45° field of view; color fundus photograph:
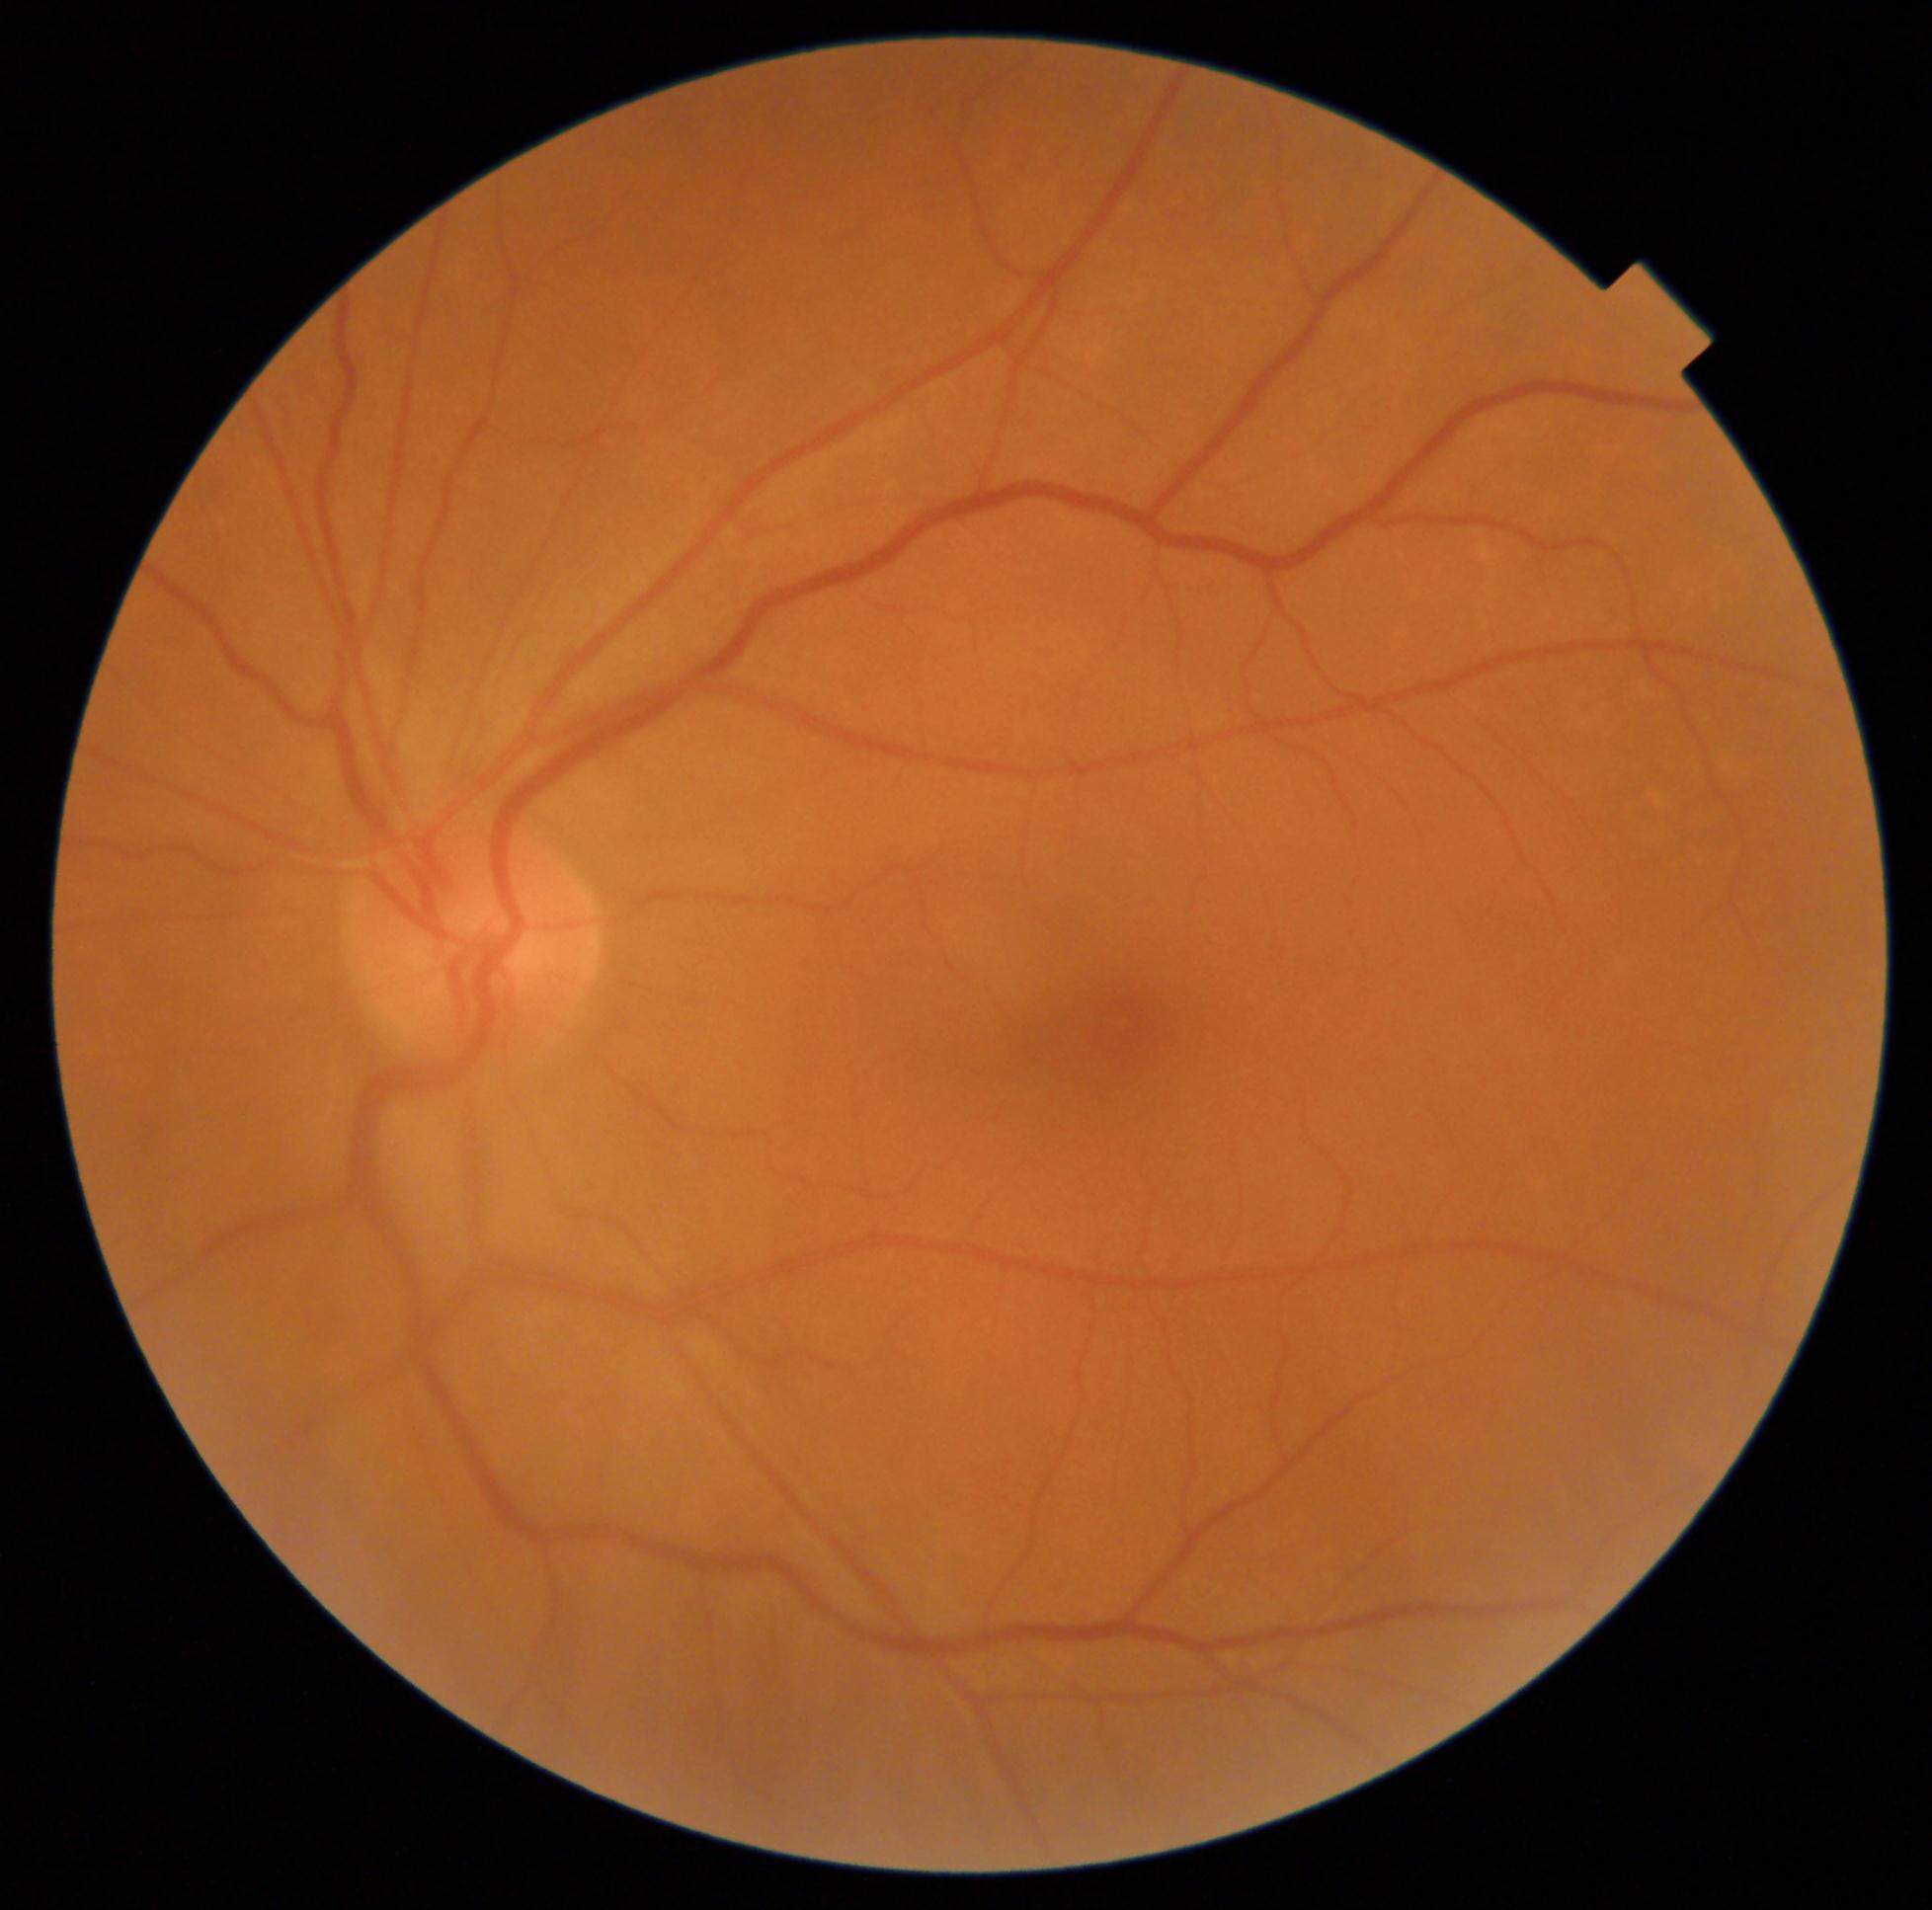
DR severity: no apparent diabetic retinopathy (grade 0).